Captured with the Clarity RetCam 3 (130° field of view). Wide-field fundus photograph from neonatal ROP screening. 640x480:
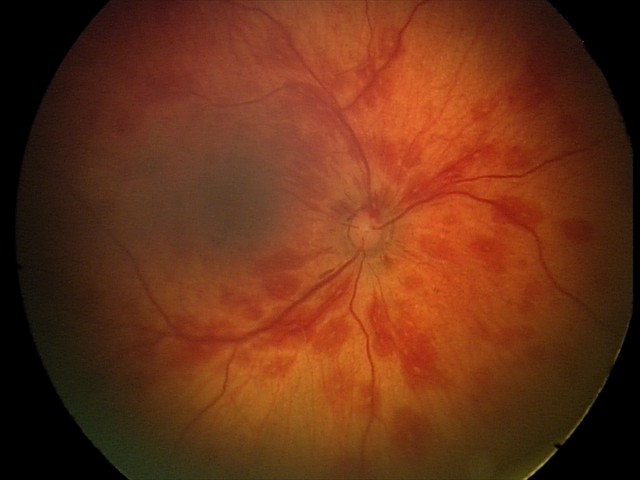 Screening examination consistent with retinal hemorrhages.